Acquired with a NIDEK AFC-230 · nonmydriatic fundus photograph · FOV: 45 degrees · 848x848 · modified Davis classification · CFP
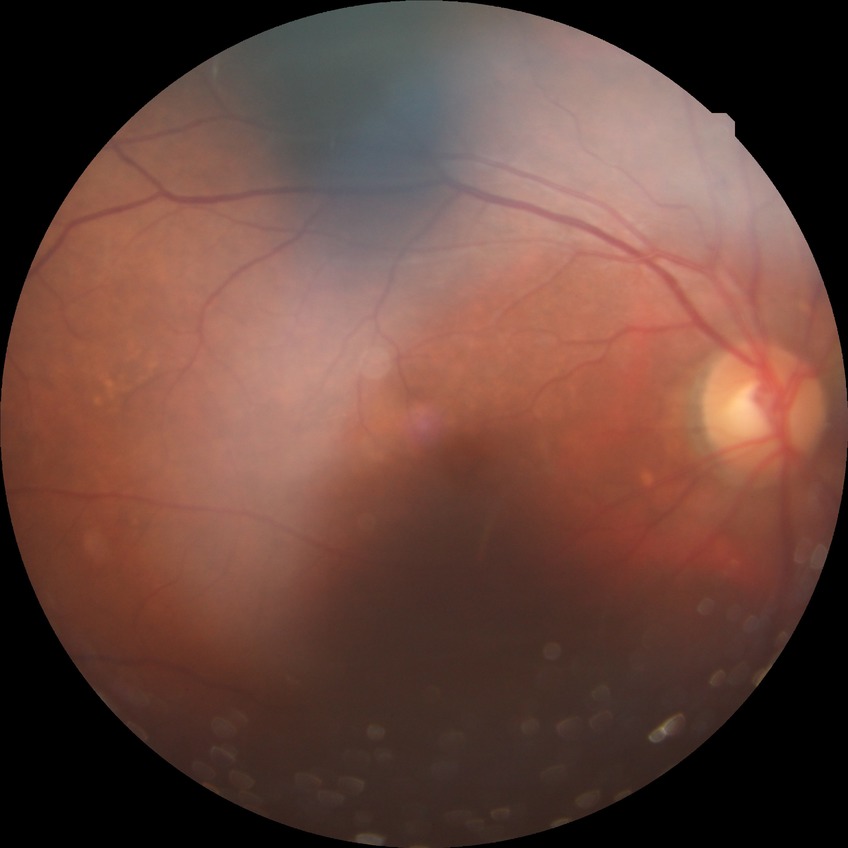

Assessment:
– modified Davis grading: no diabetic retinopathy